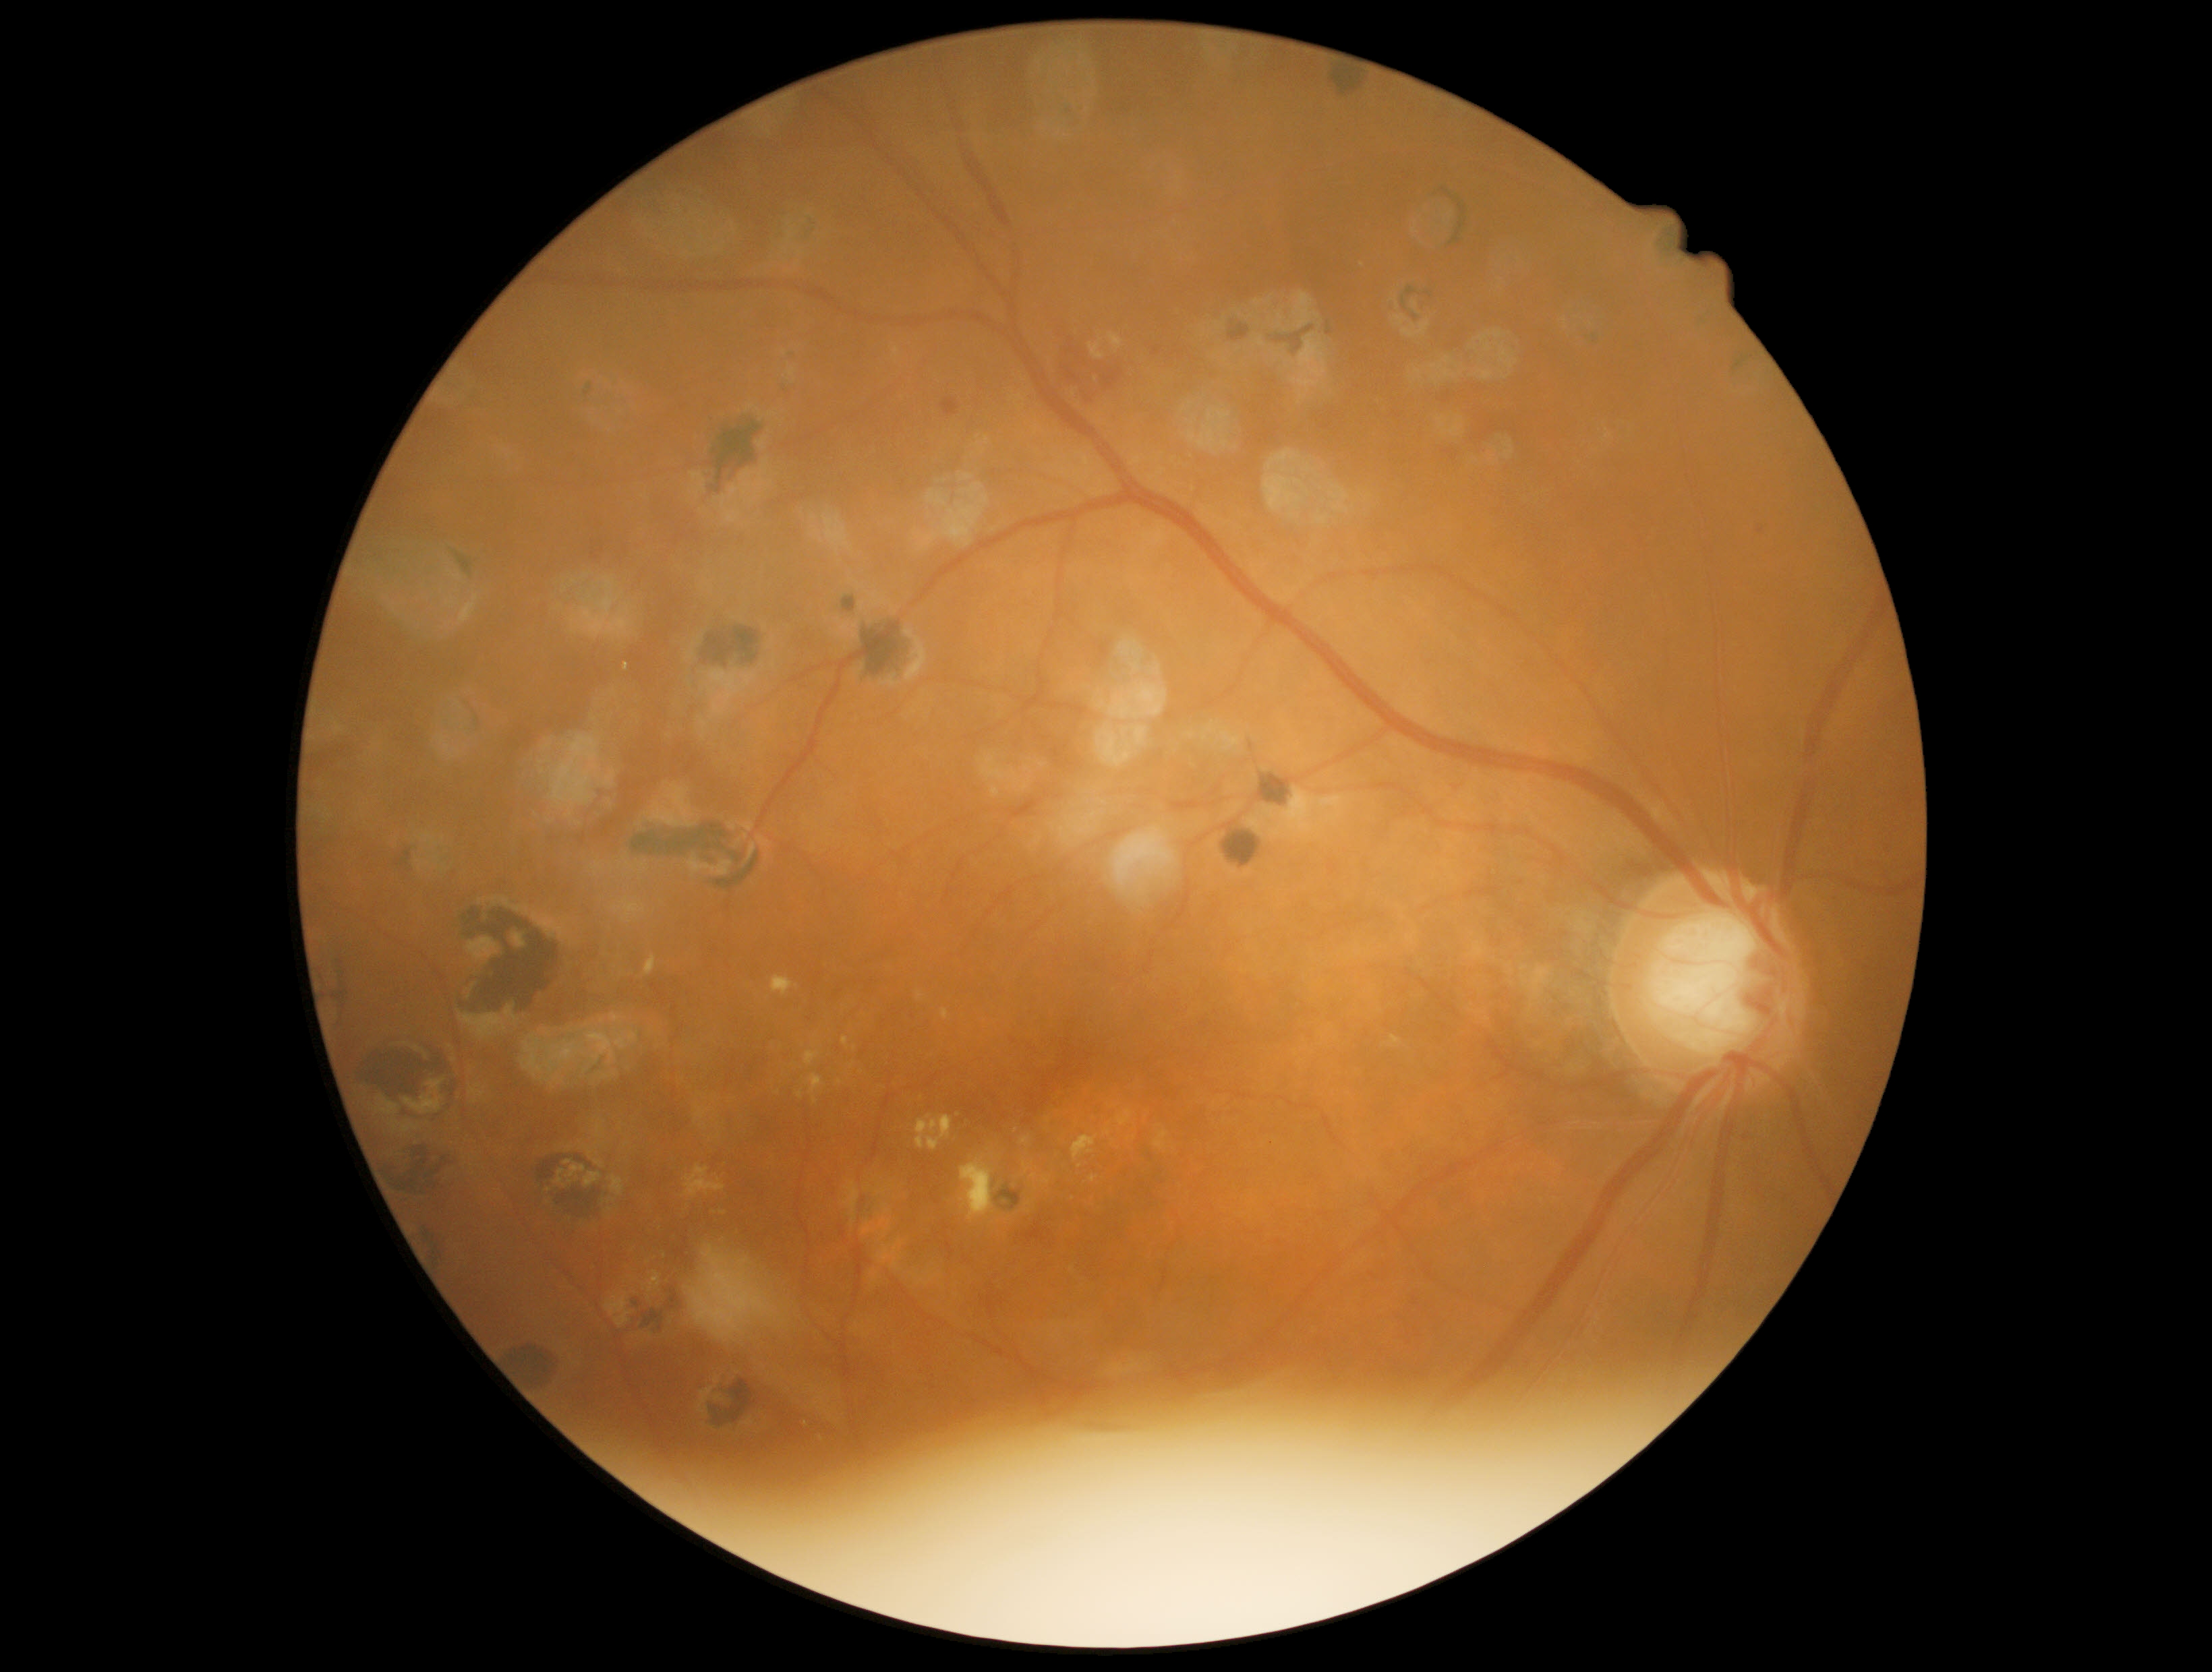

Retinopathy grade is 2/4.